Without pupil dilation · modified Davis classification · 45-degree field of view.
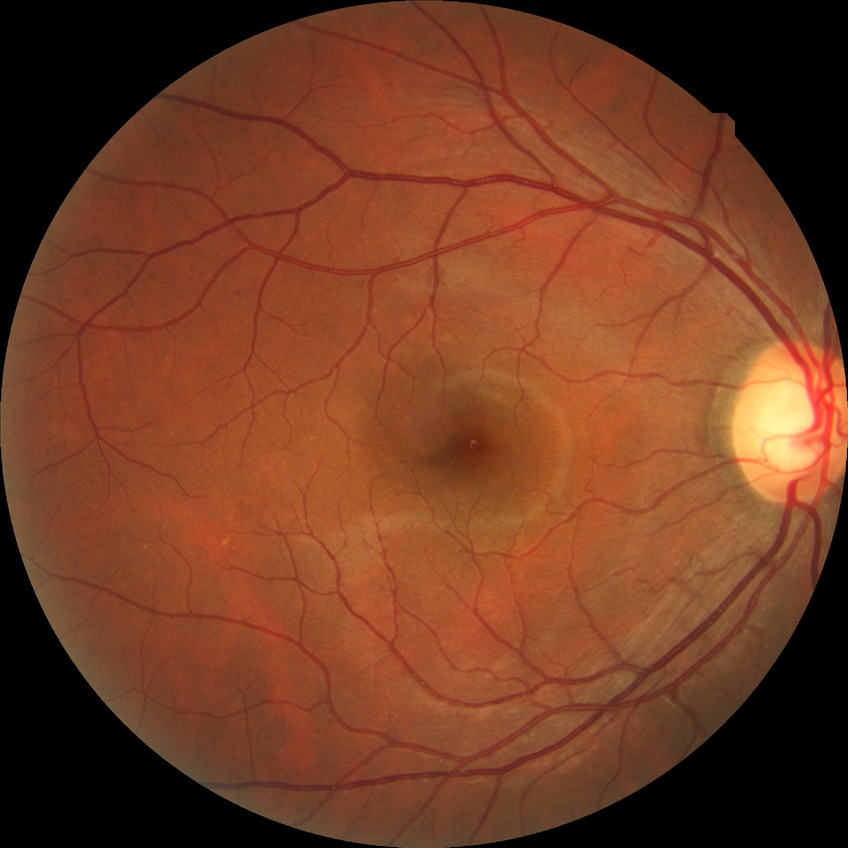 Modified Davis grading is no diabetic retinopathy.